Color fundus photograph; 240x240
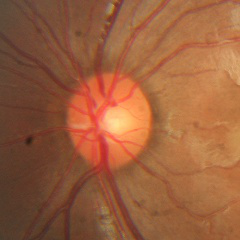

No glaucomatous findings.